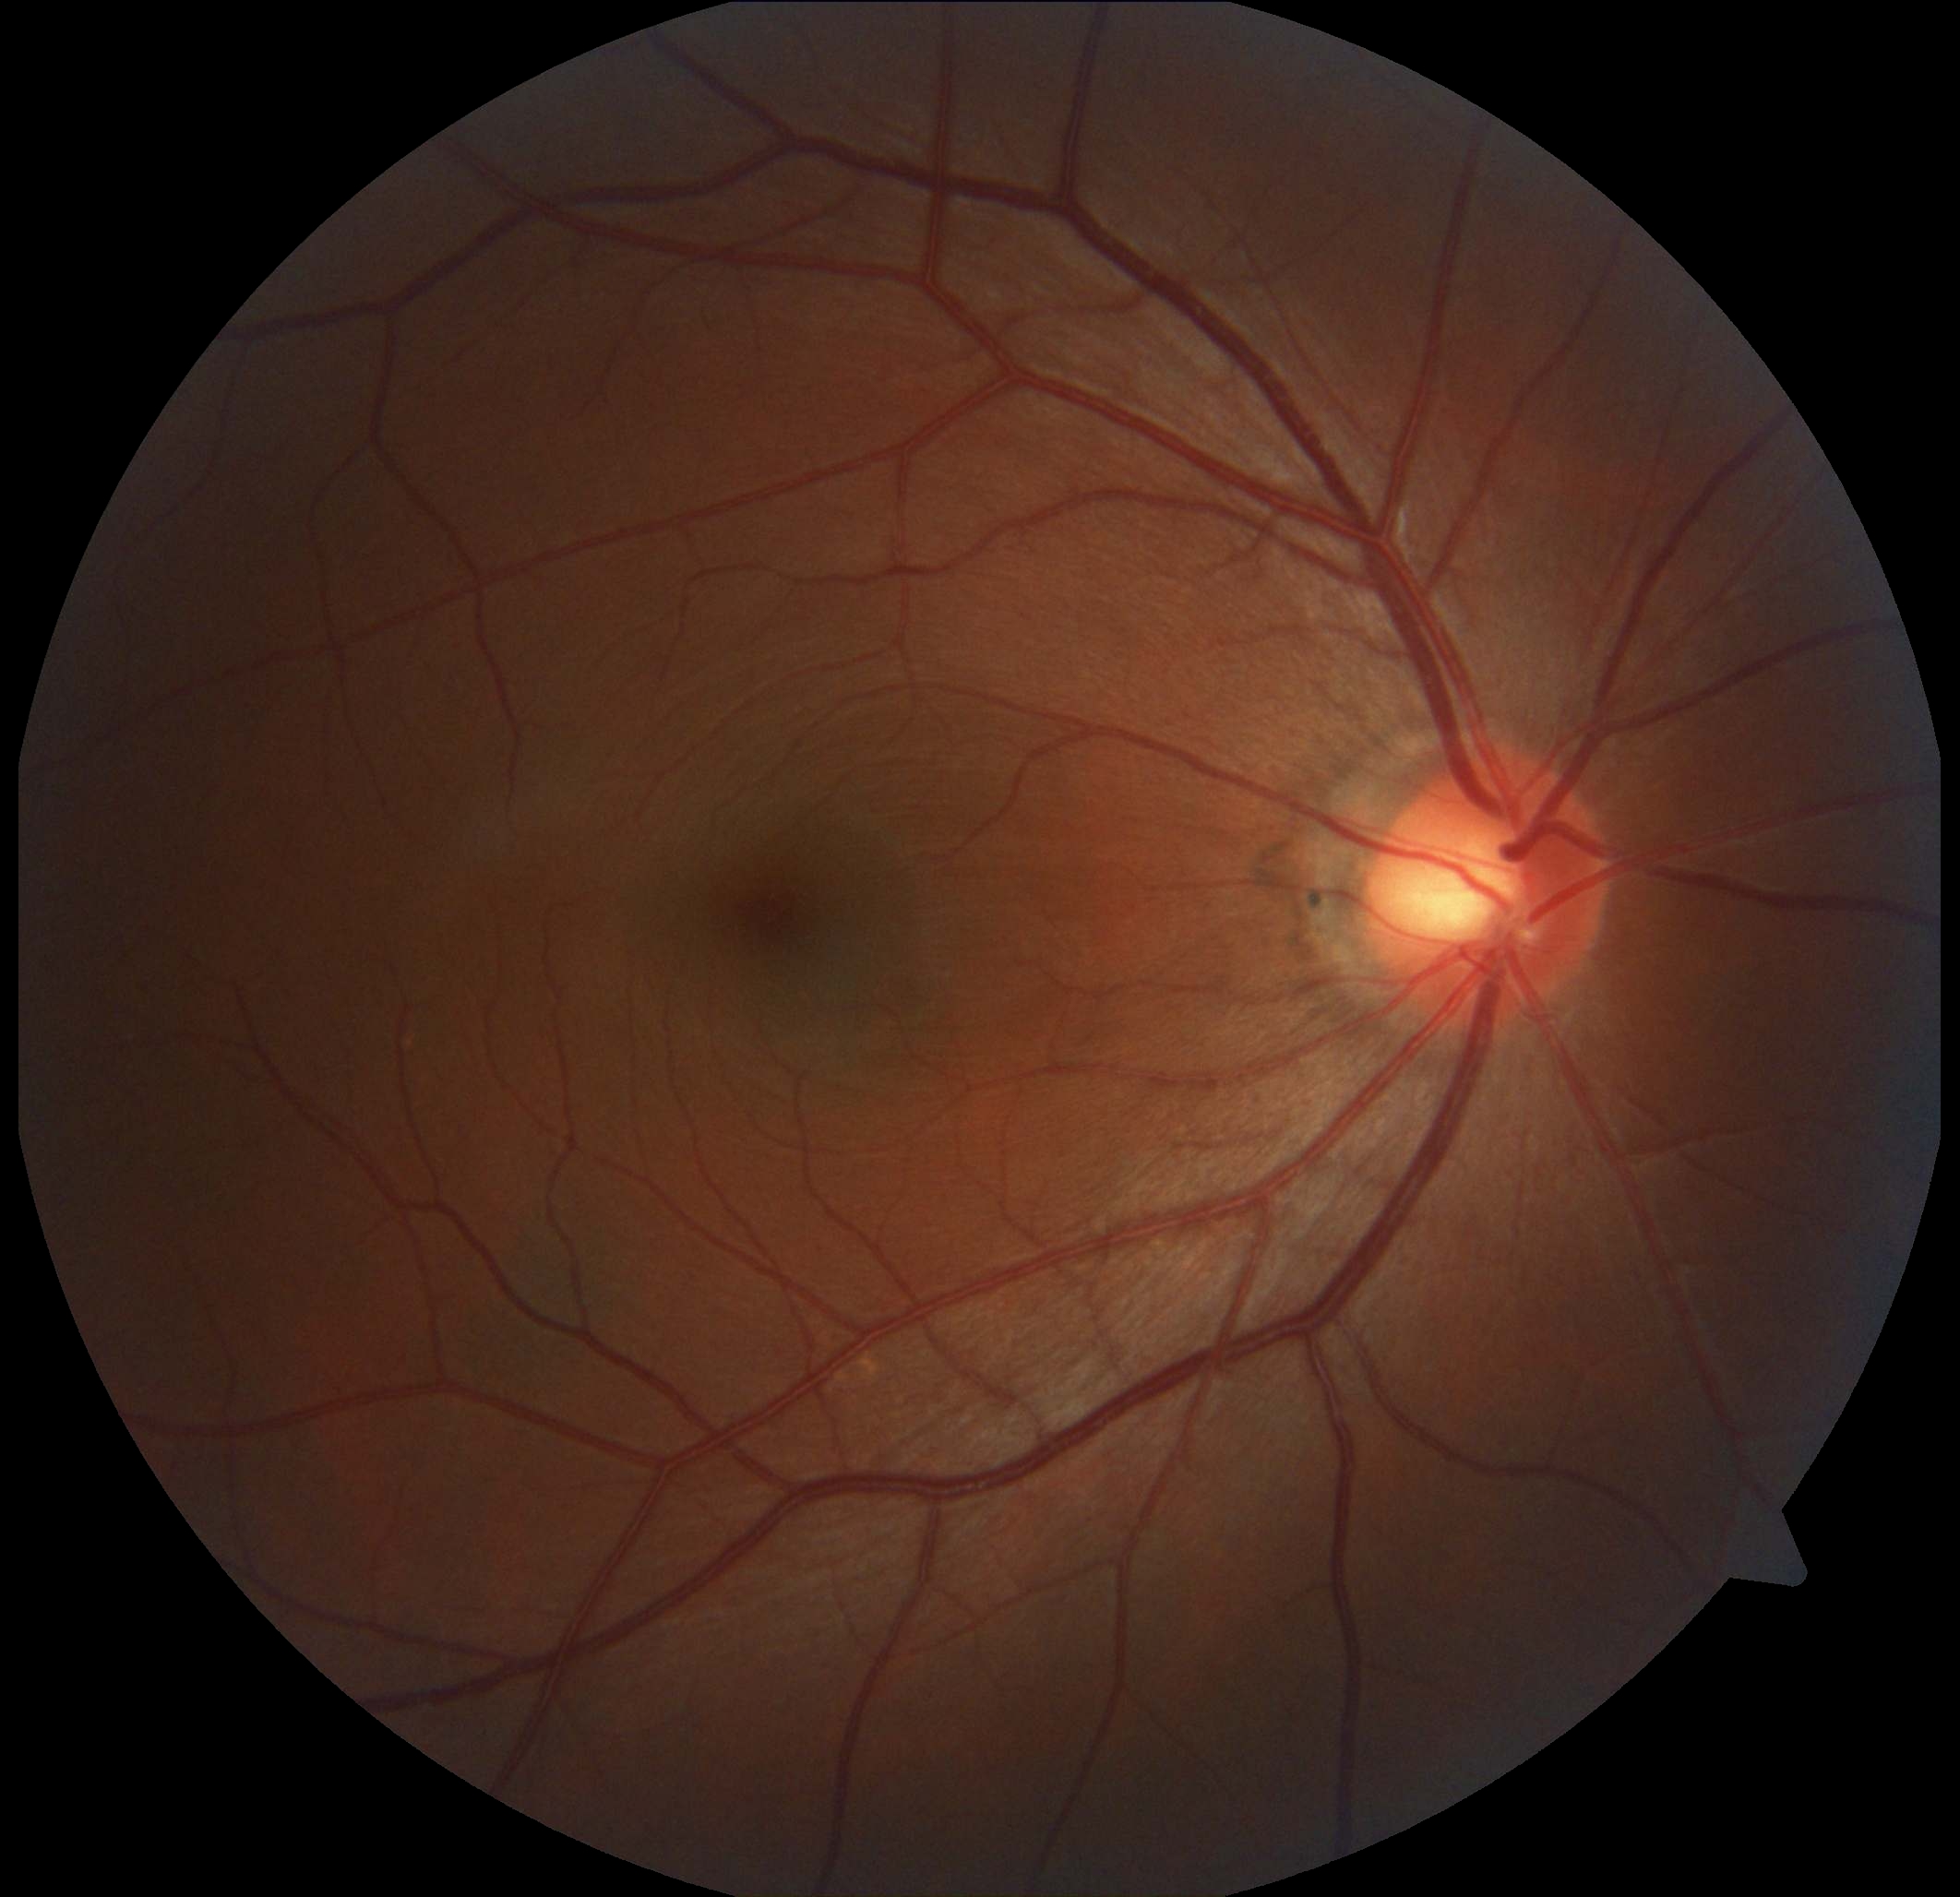
diabetic retinopathy grade=0.